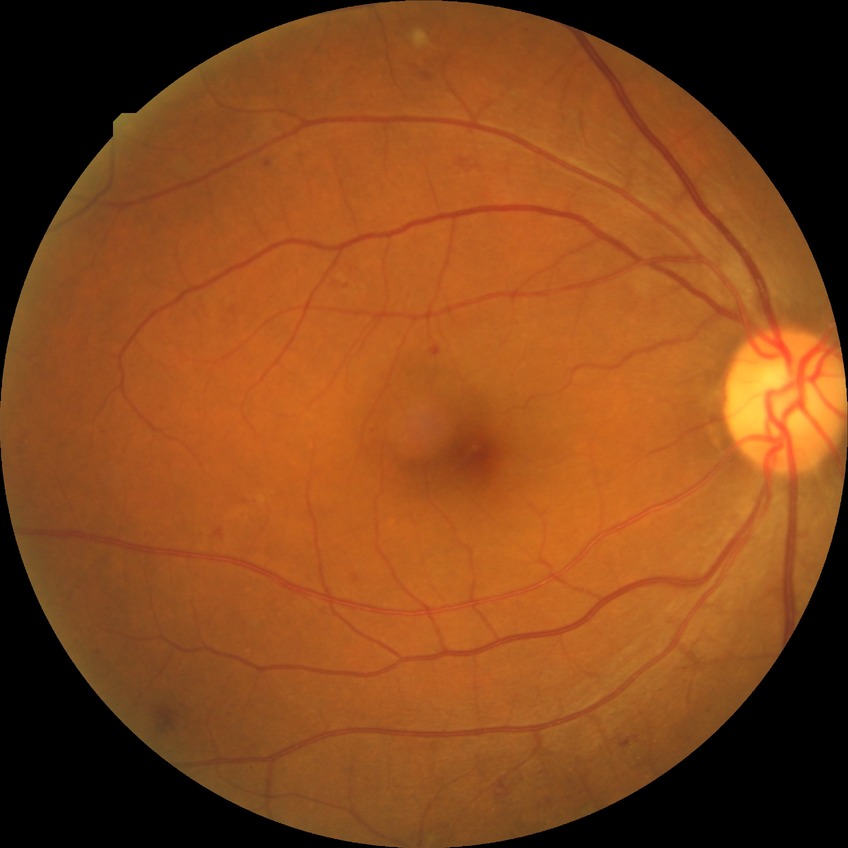
Diabetic retinopathy (DR): SDR (simple diabetic retinopathy).